Diabetic retinopathy graded by the modified Davis classification
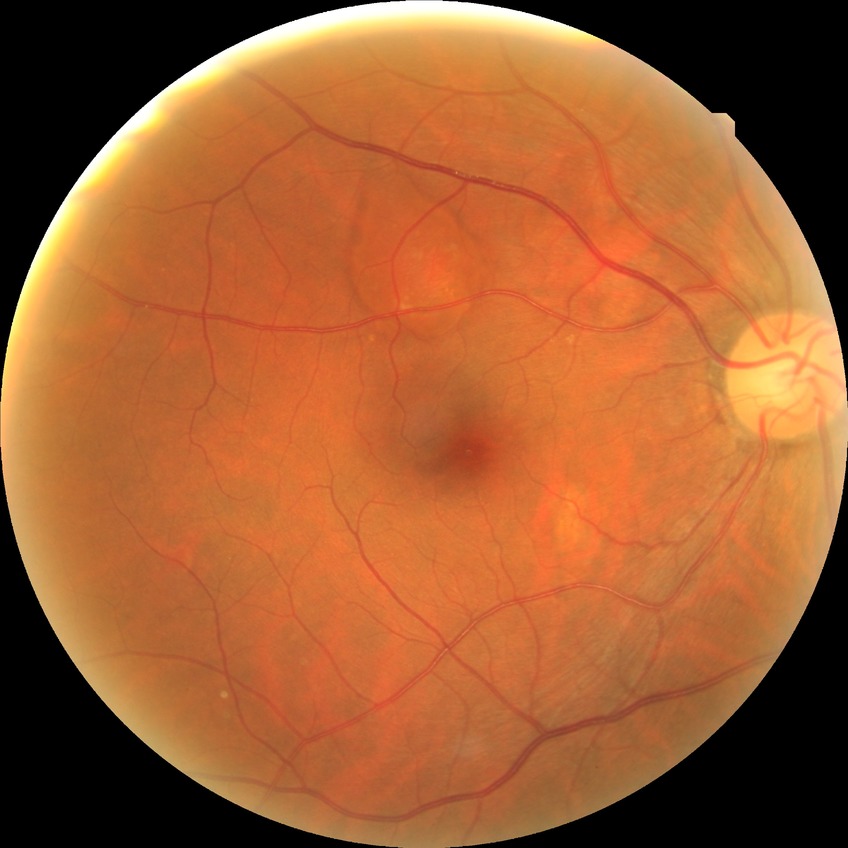 Assessment:
* diabetic retinopathy severity: no diabetic retinopathy